Wide-field fundus photograph of an infant; 640x480px.
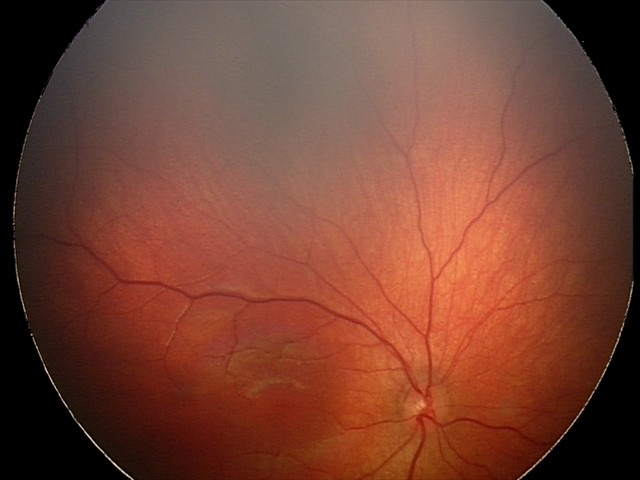 Screening examination consistent with retinal hemorrhages.